Infant wide-field fundus photograph: 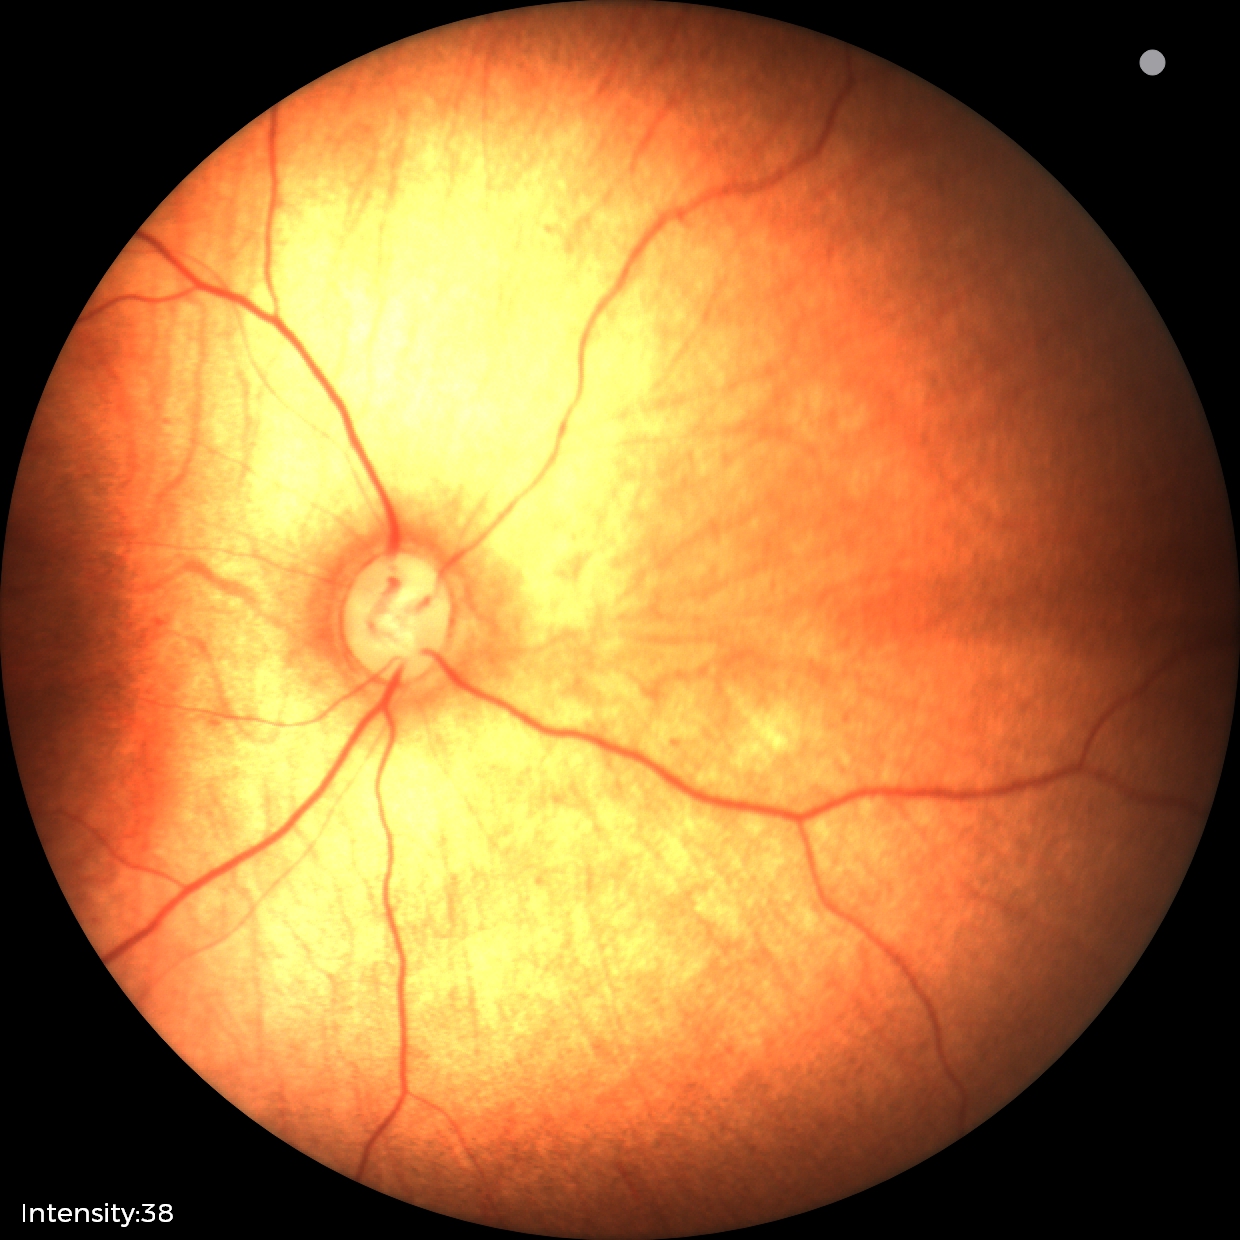
Screening diagnosis: normal.